Nonmydriatic fundus photograph · 45 degree fundus photograph
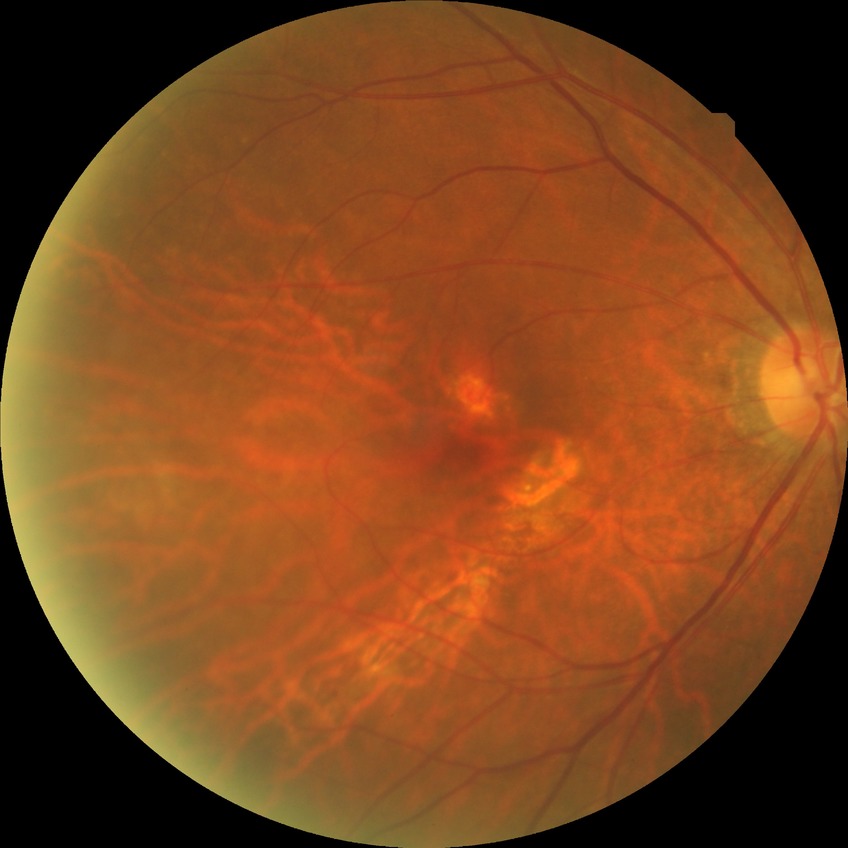

diabetic retinopathy (DR): no diabetic retinopathy (NDR).